640 x 480 pixels. RetCam wide-field infant fundus image: 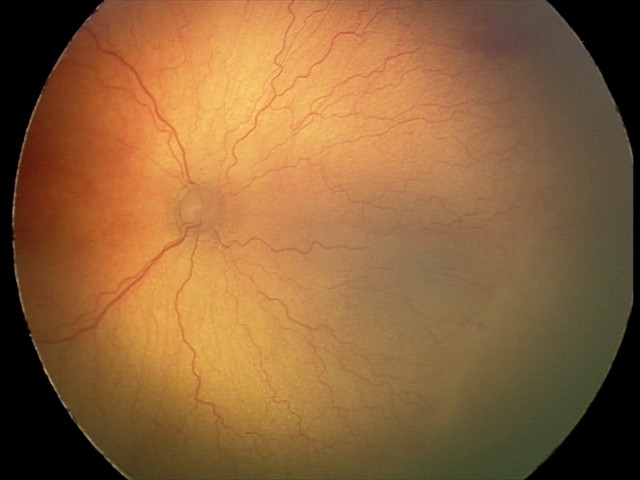

Assessment: aggressive retinopathy of prematurity
plus disease: present